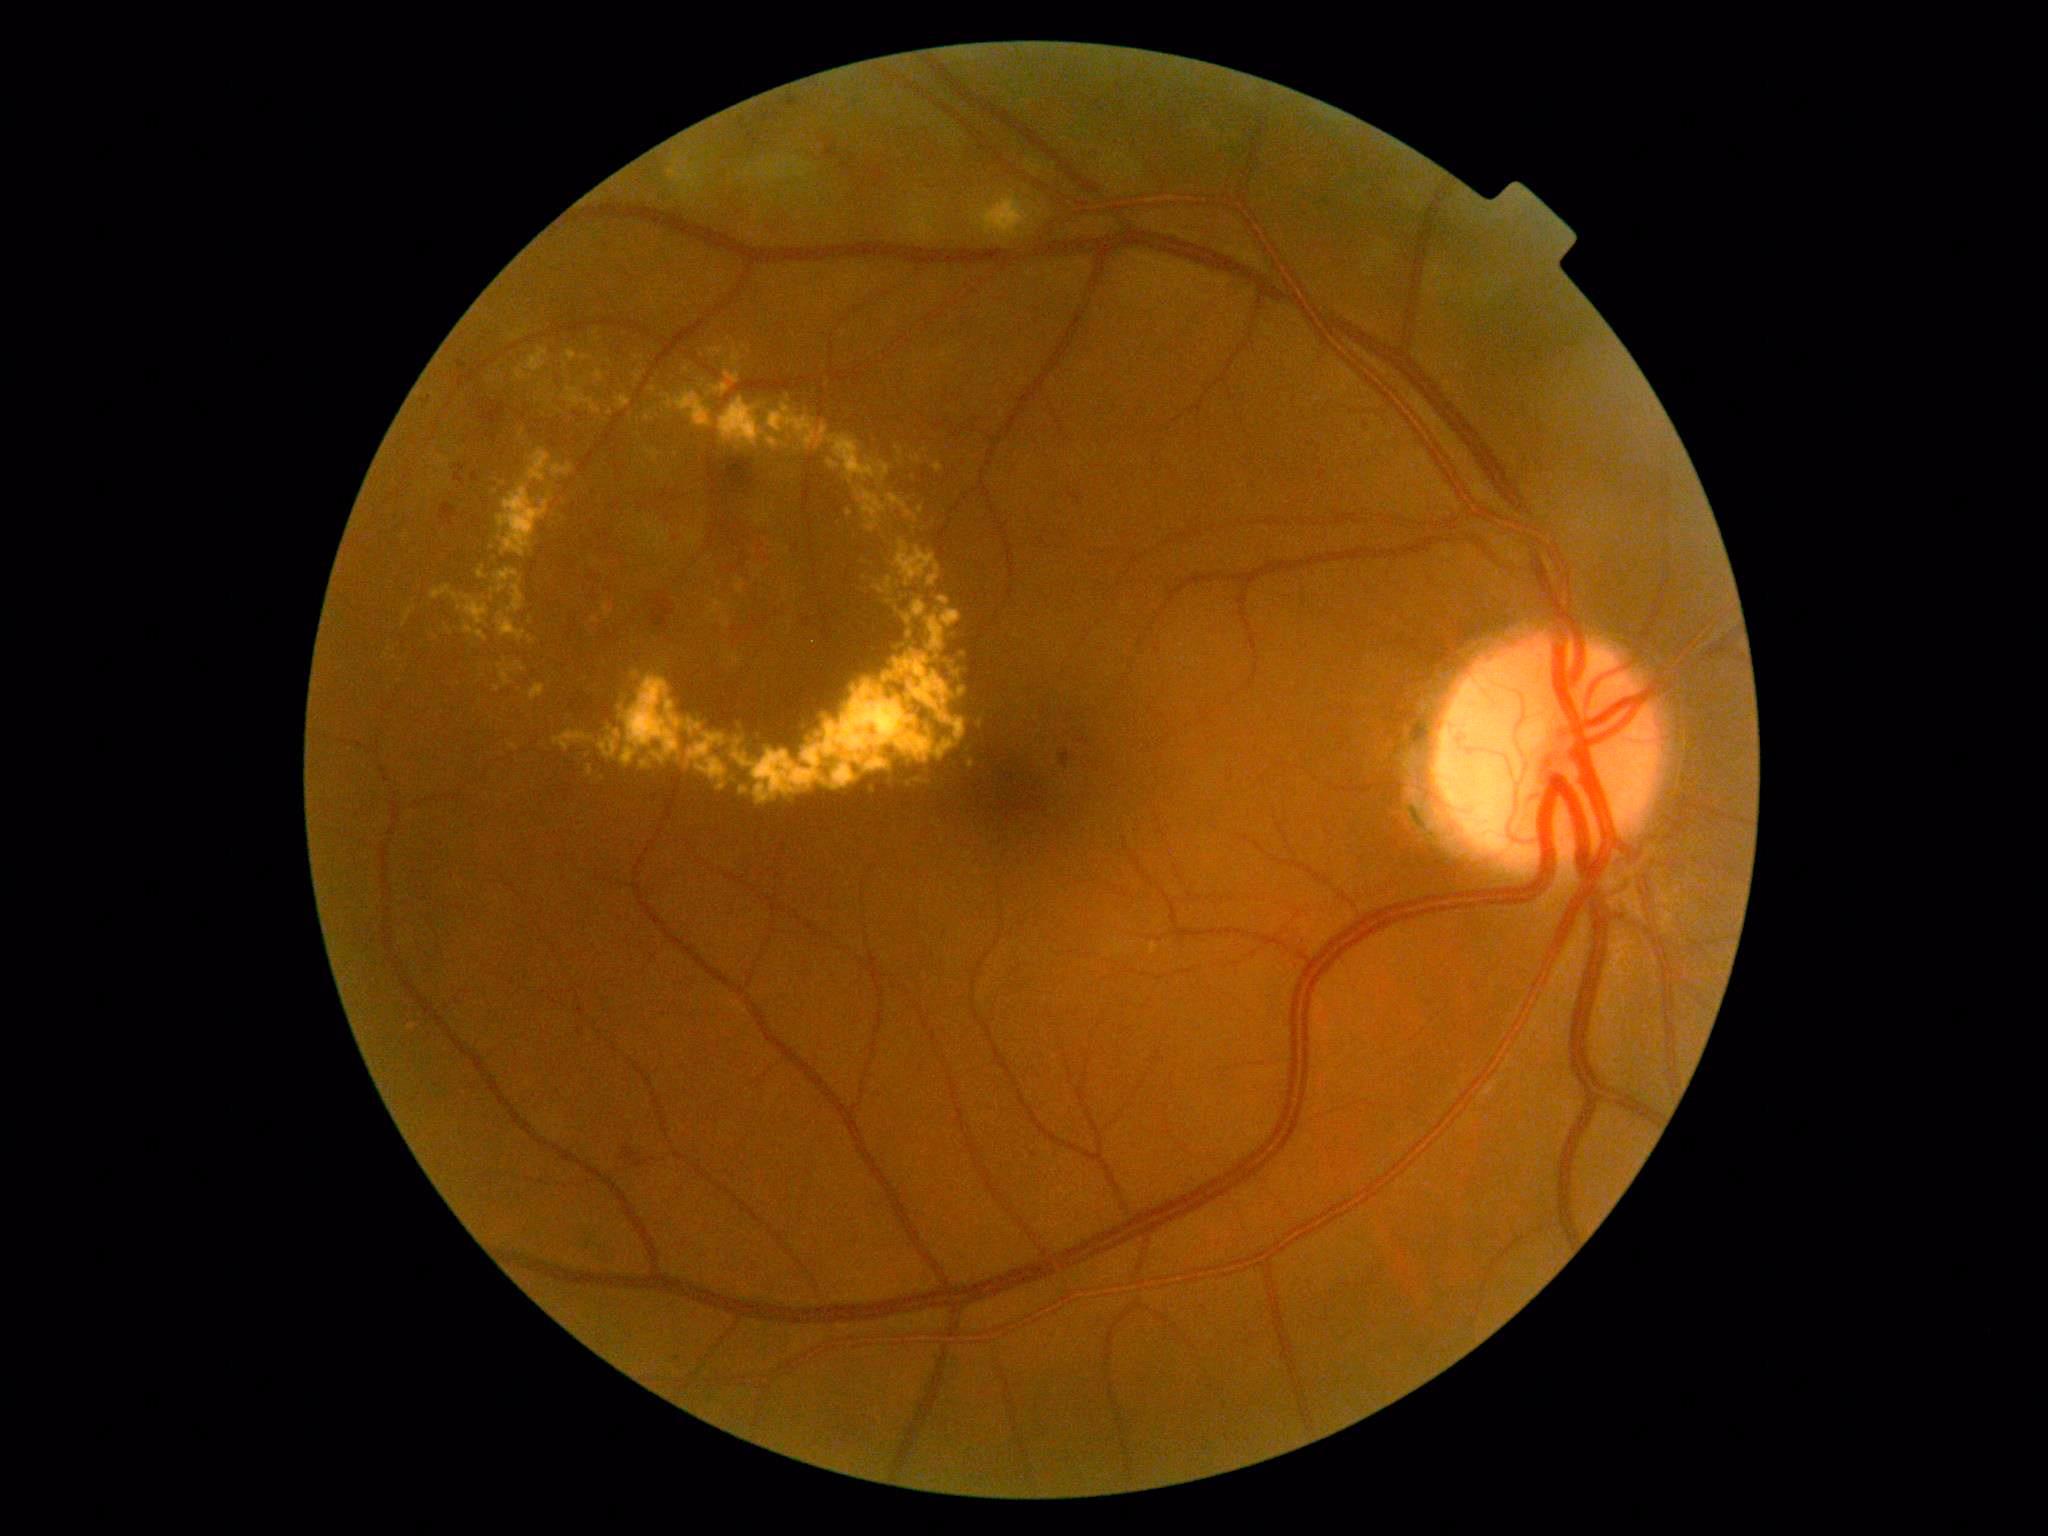
The retinopathy is classified as non-proliferative diabetic retinopathy. Diabetic retinopathy (DR) is 2/4.